Disc-centered field:
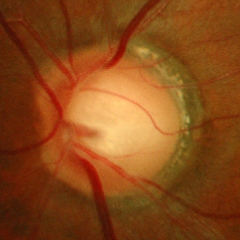
Glaucomatous changes are present. Diagnosis = early glaucoma.